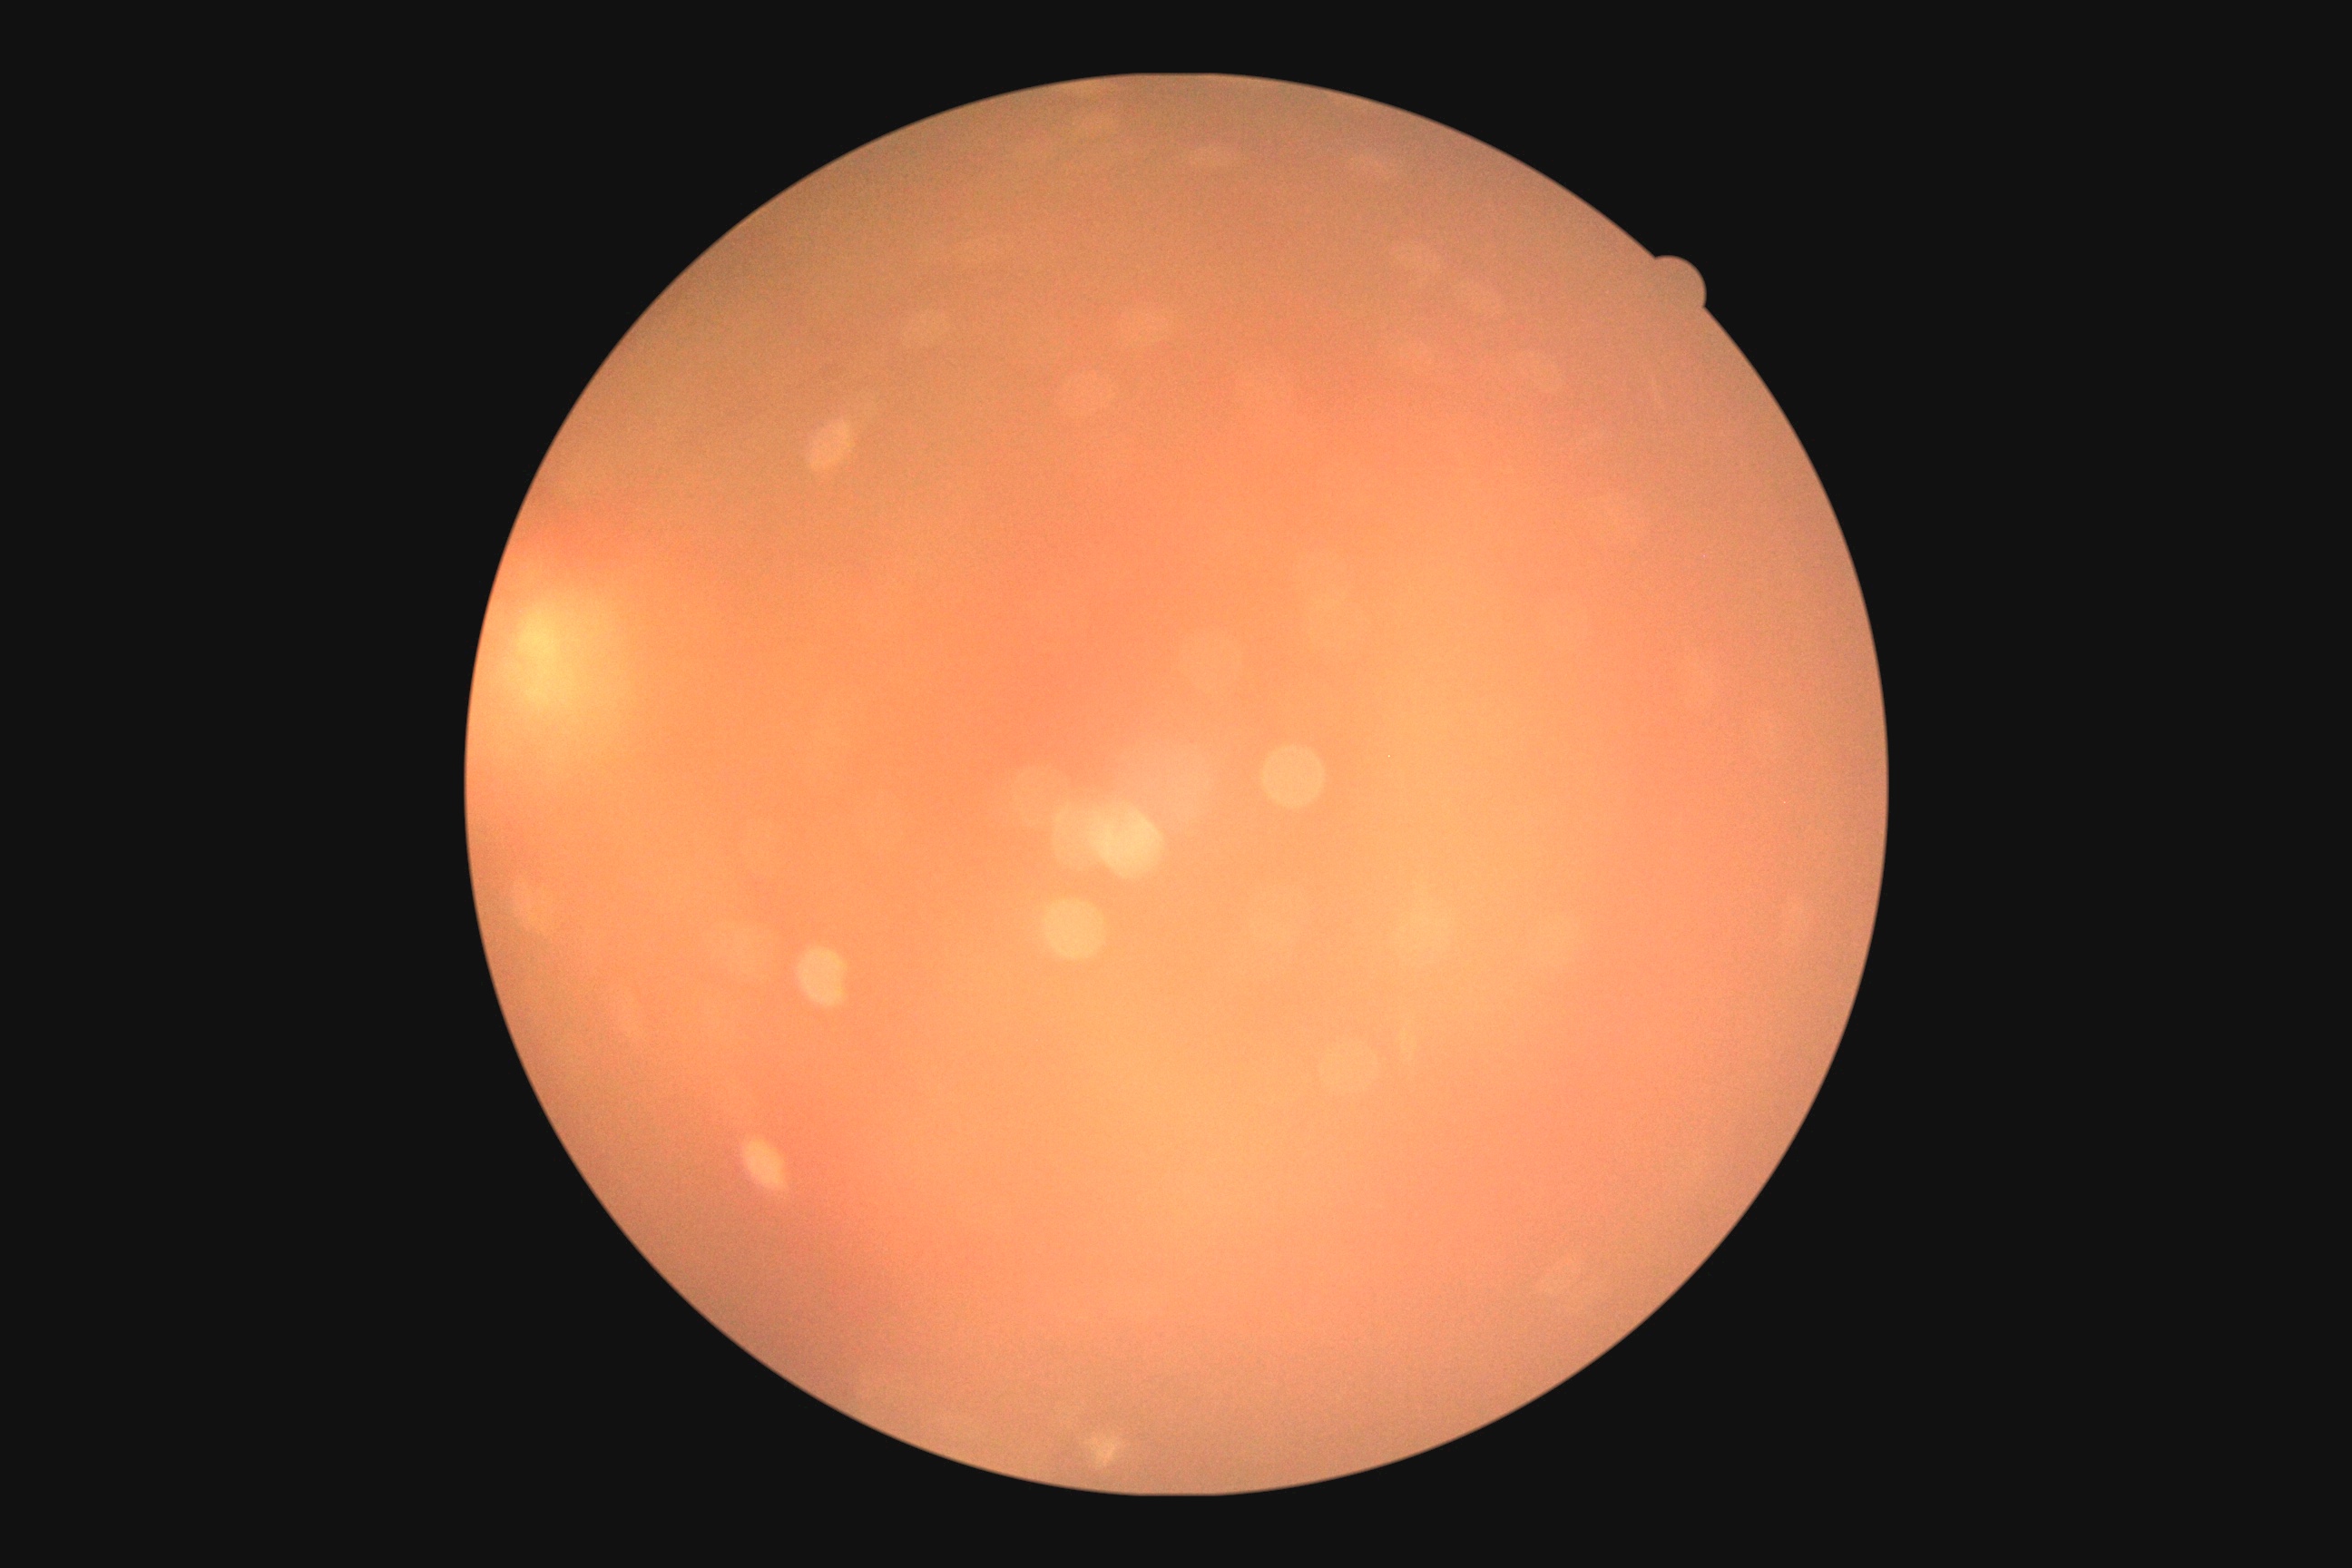
DR is ungradable.